CFP — 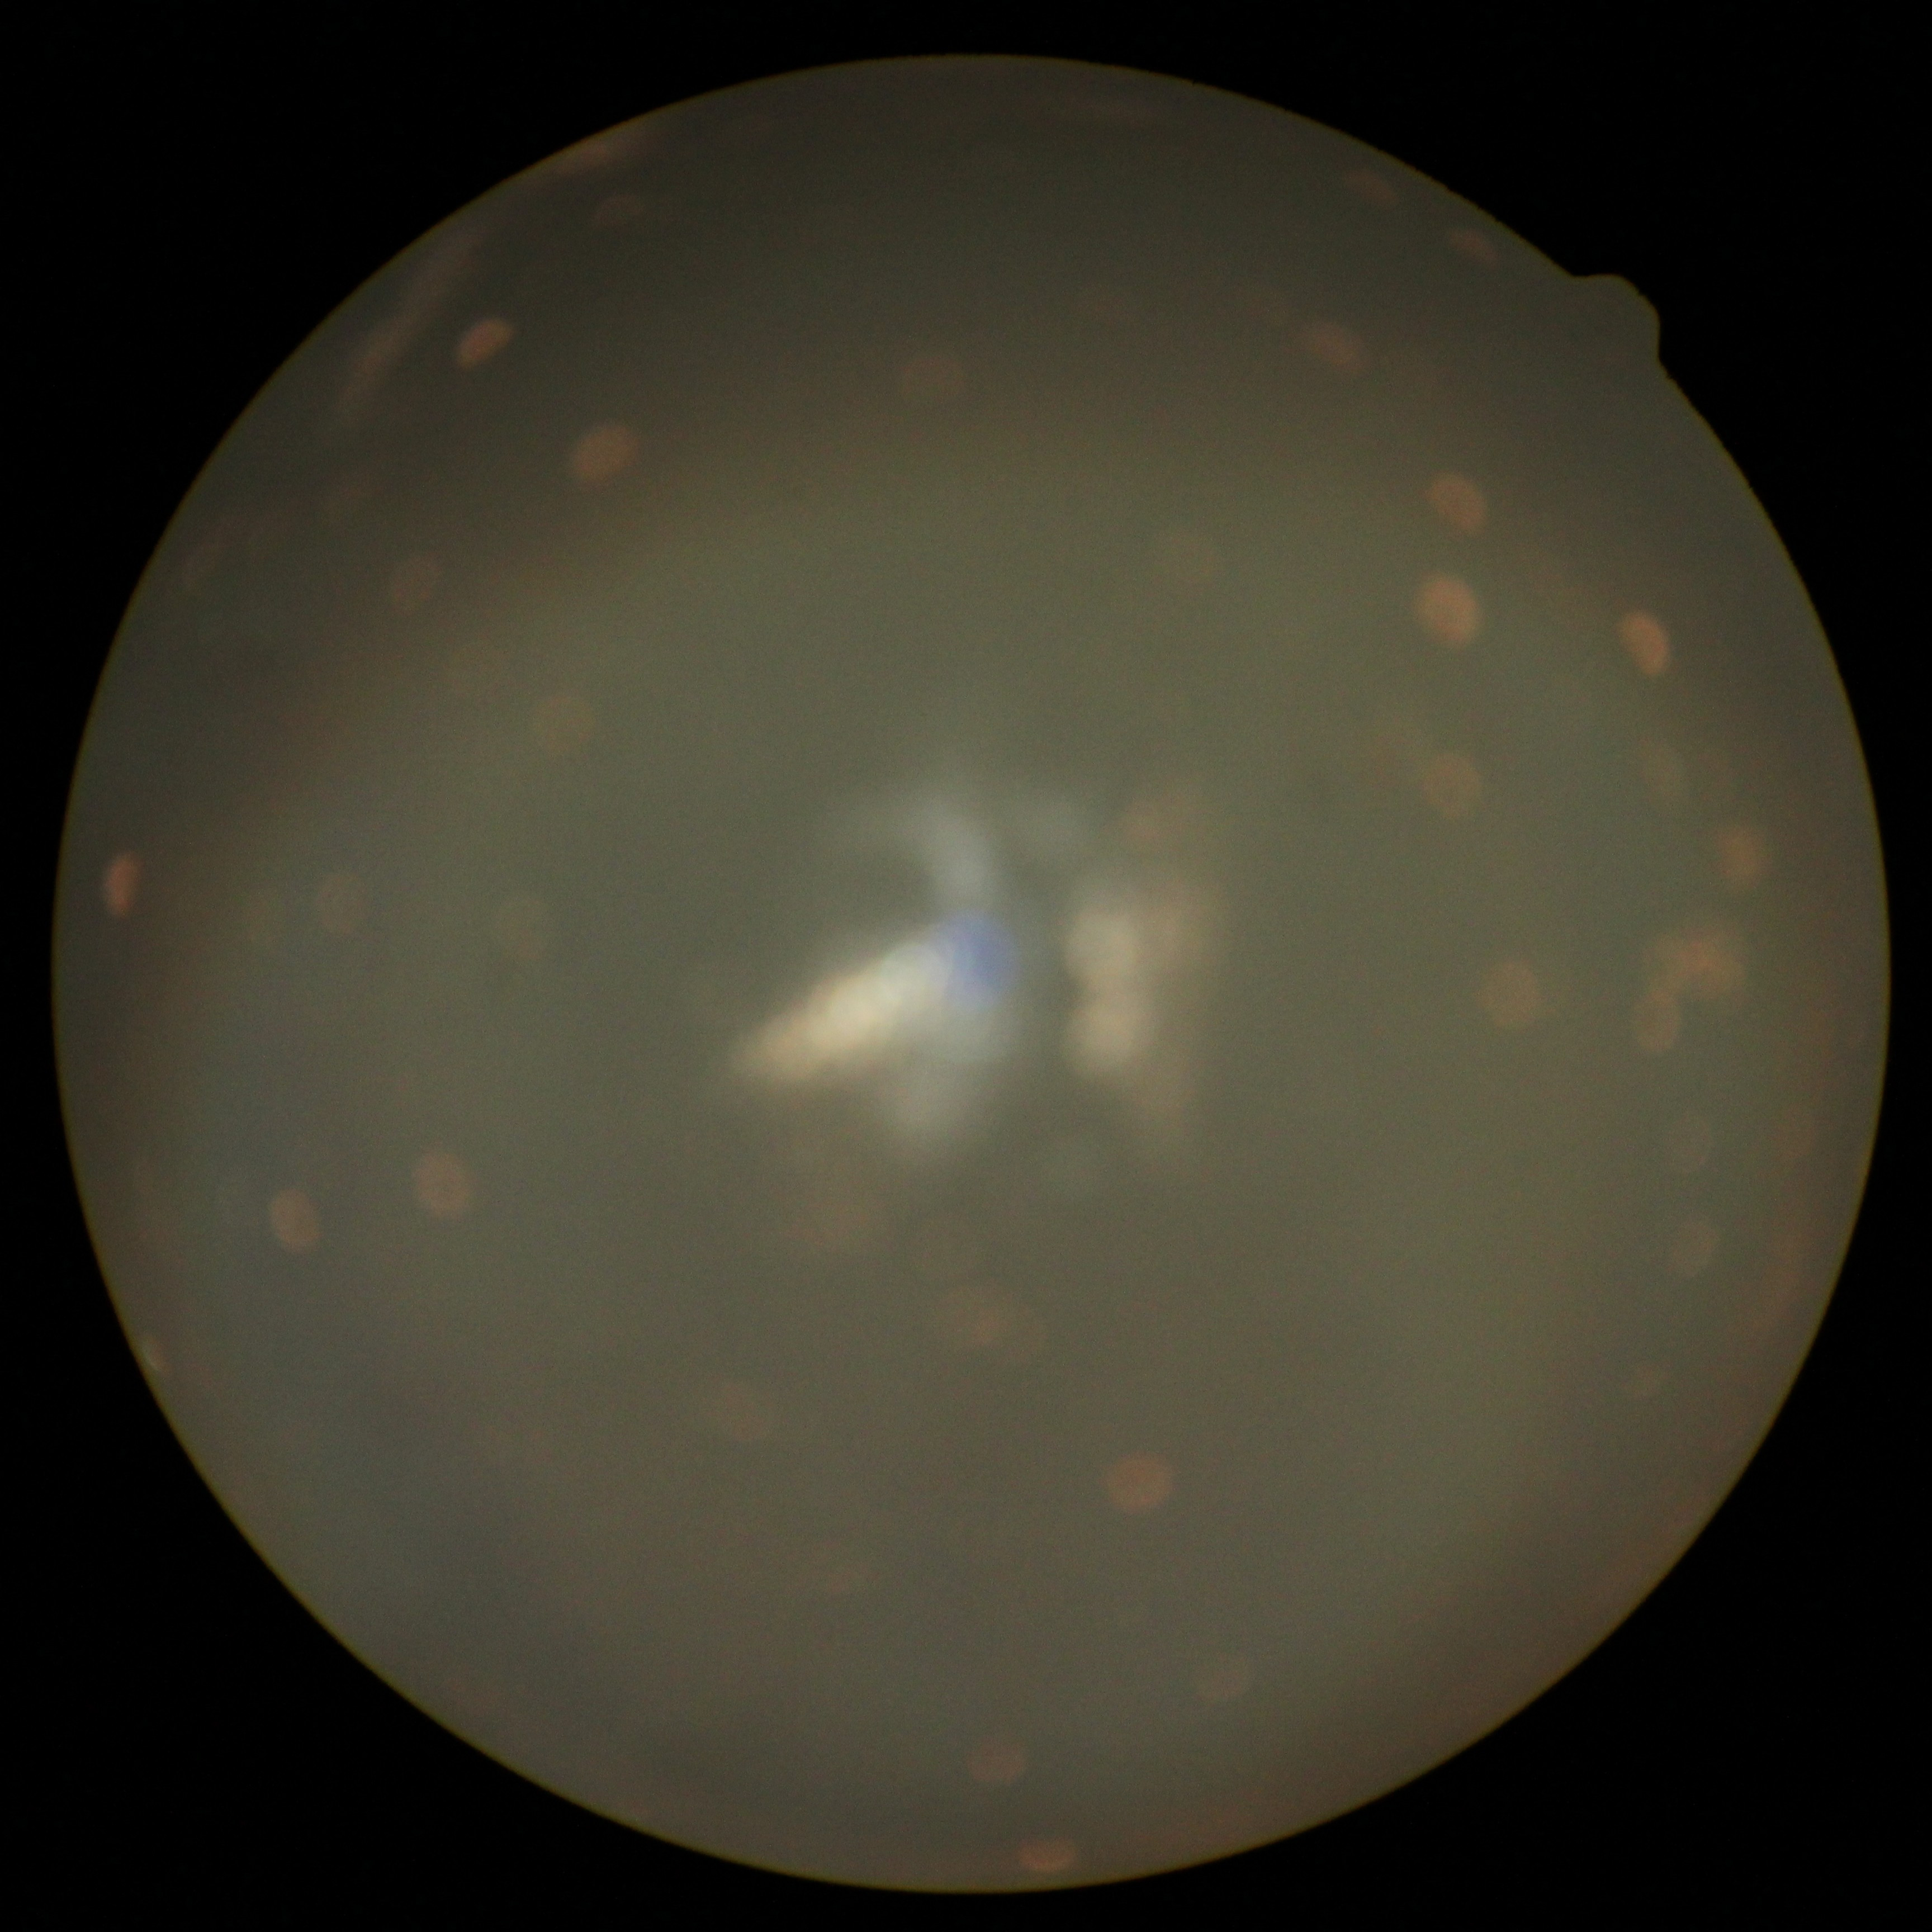
DR stage is ungradable.